Retinal fundus photograph · 2352 x 1568 pixels
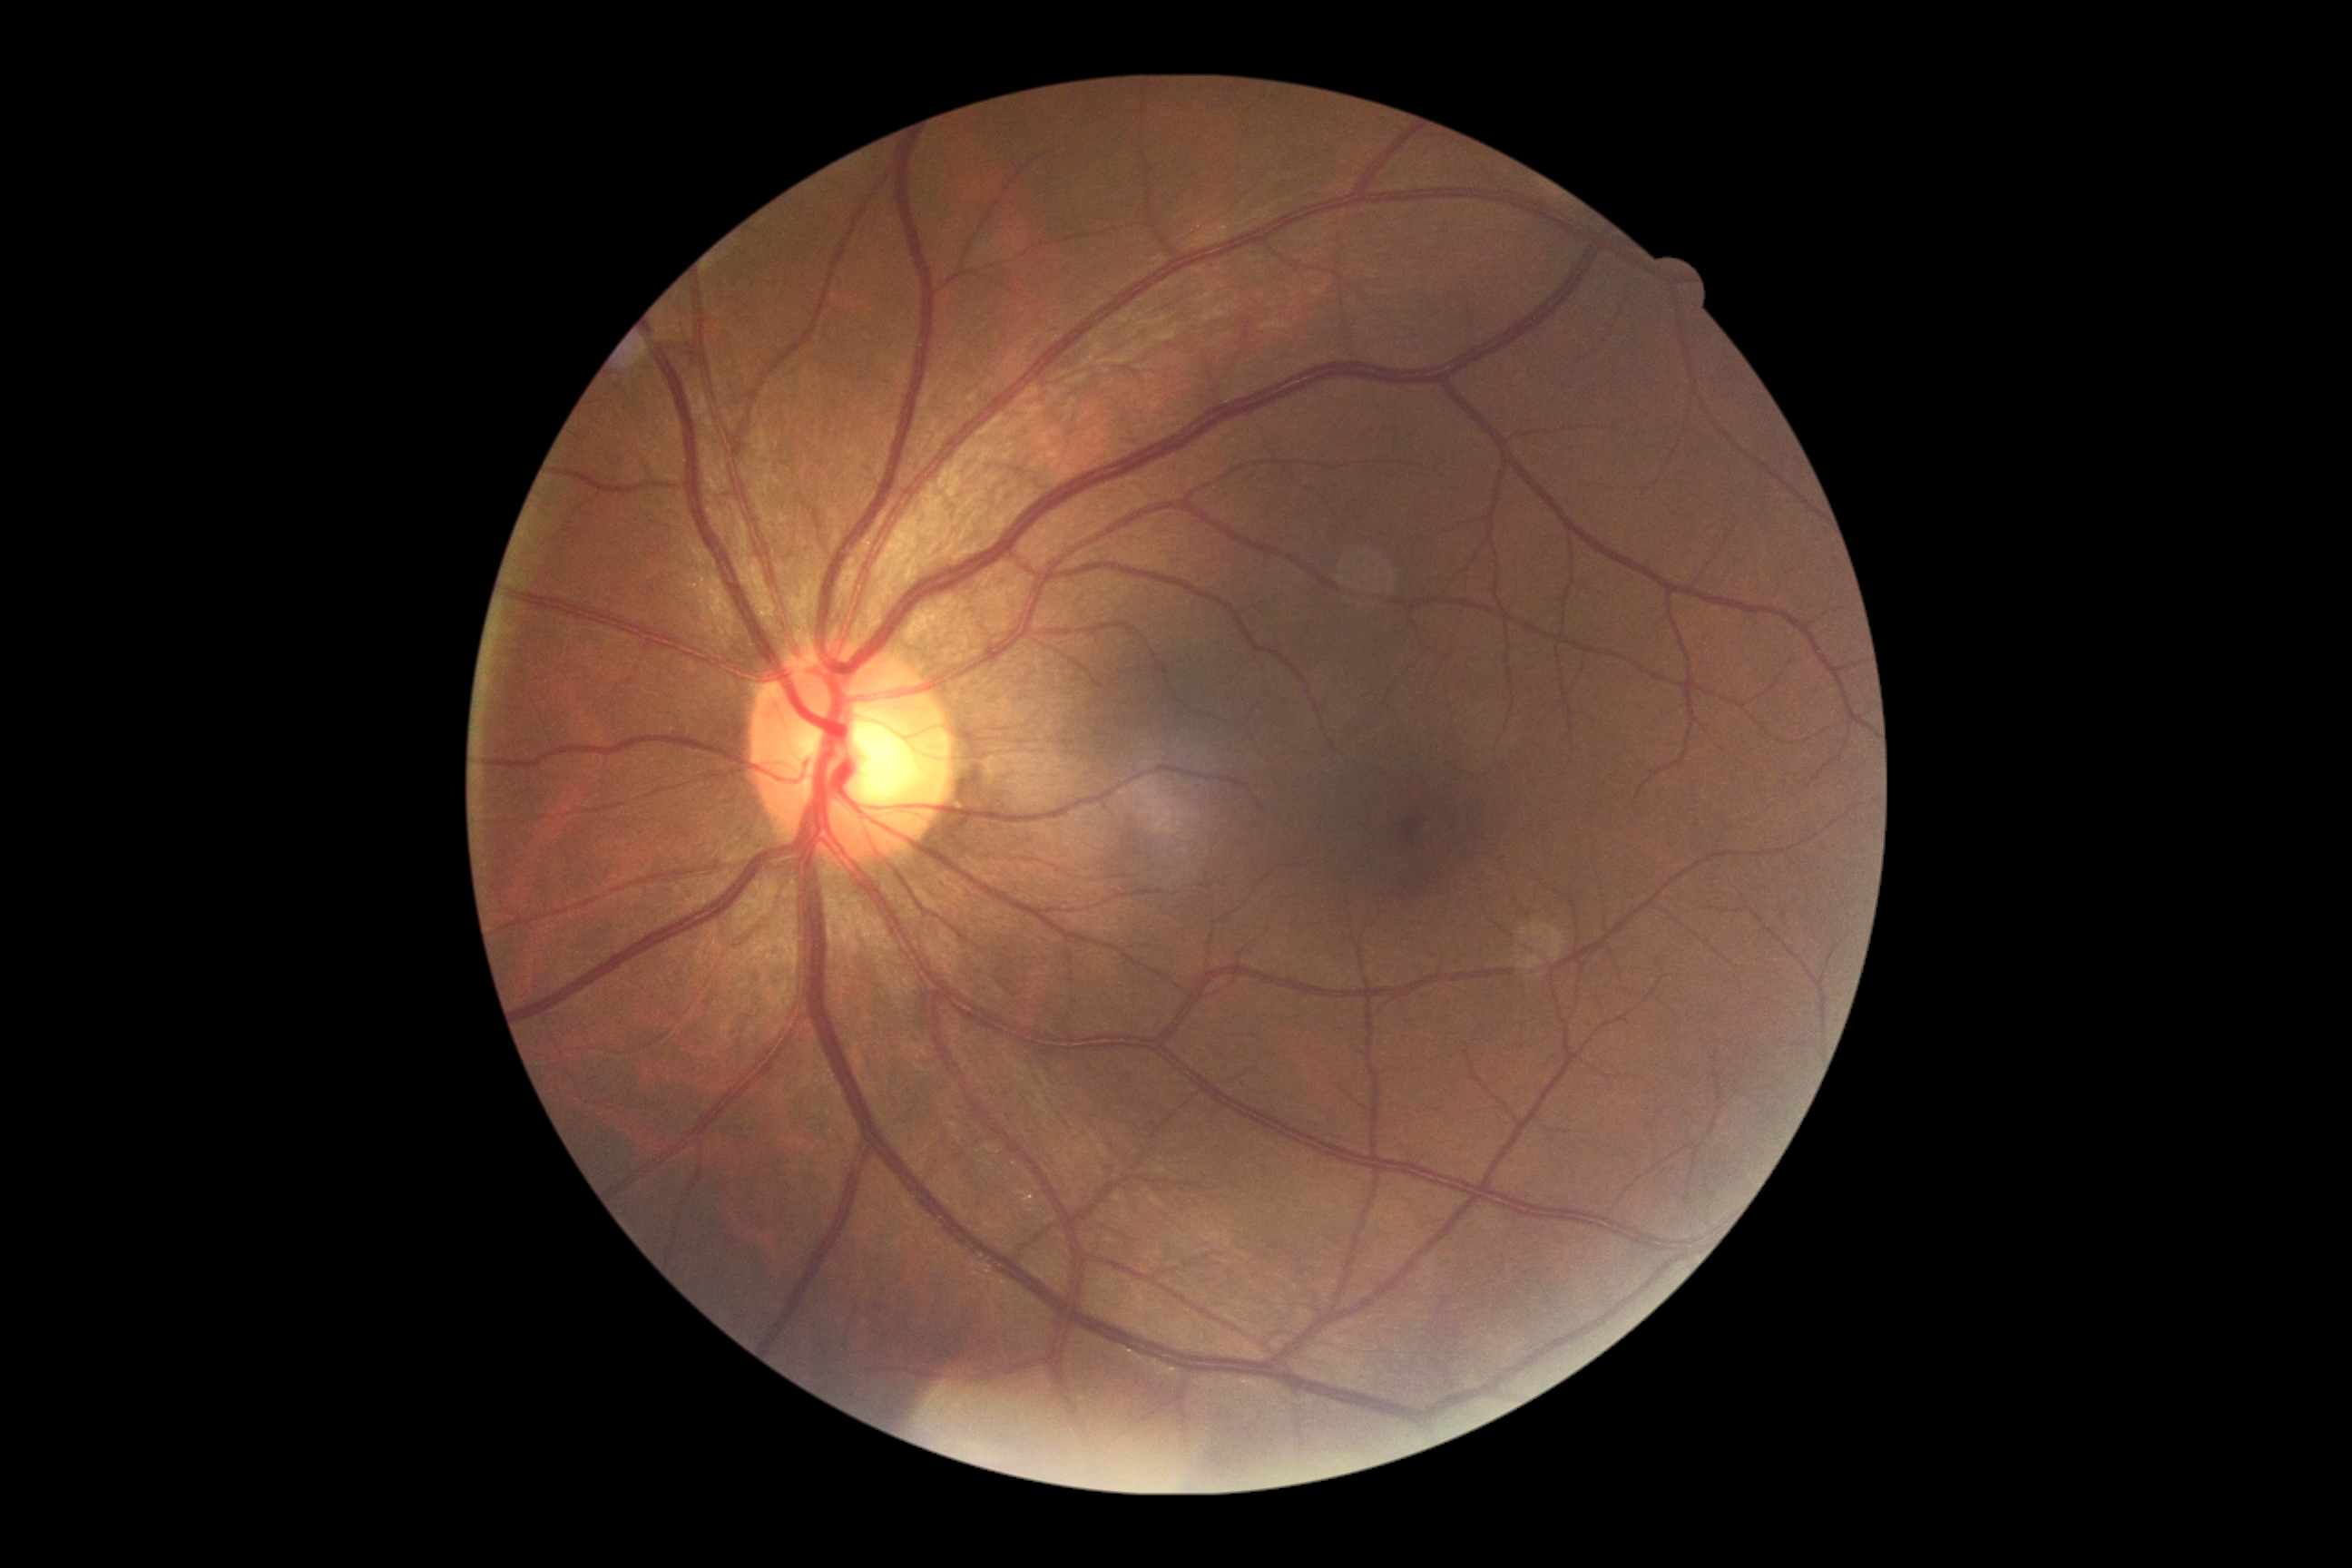
DR severity=0/4.